45-degree field of view: 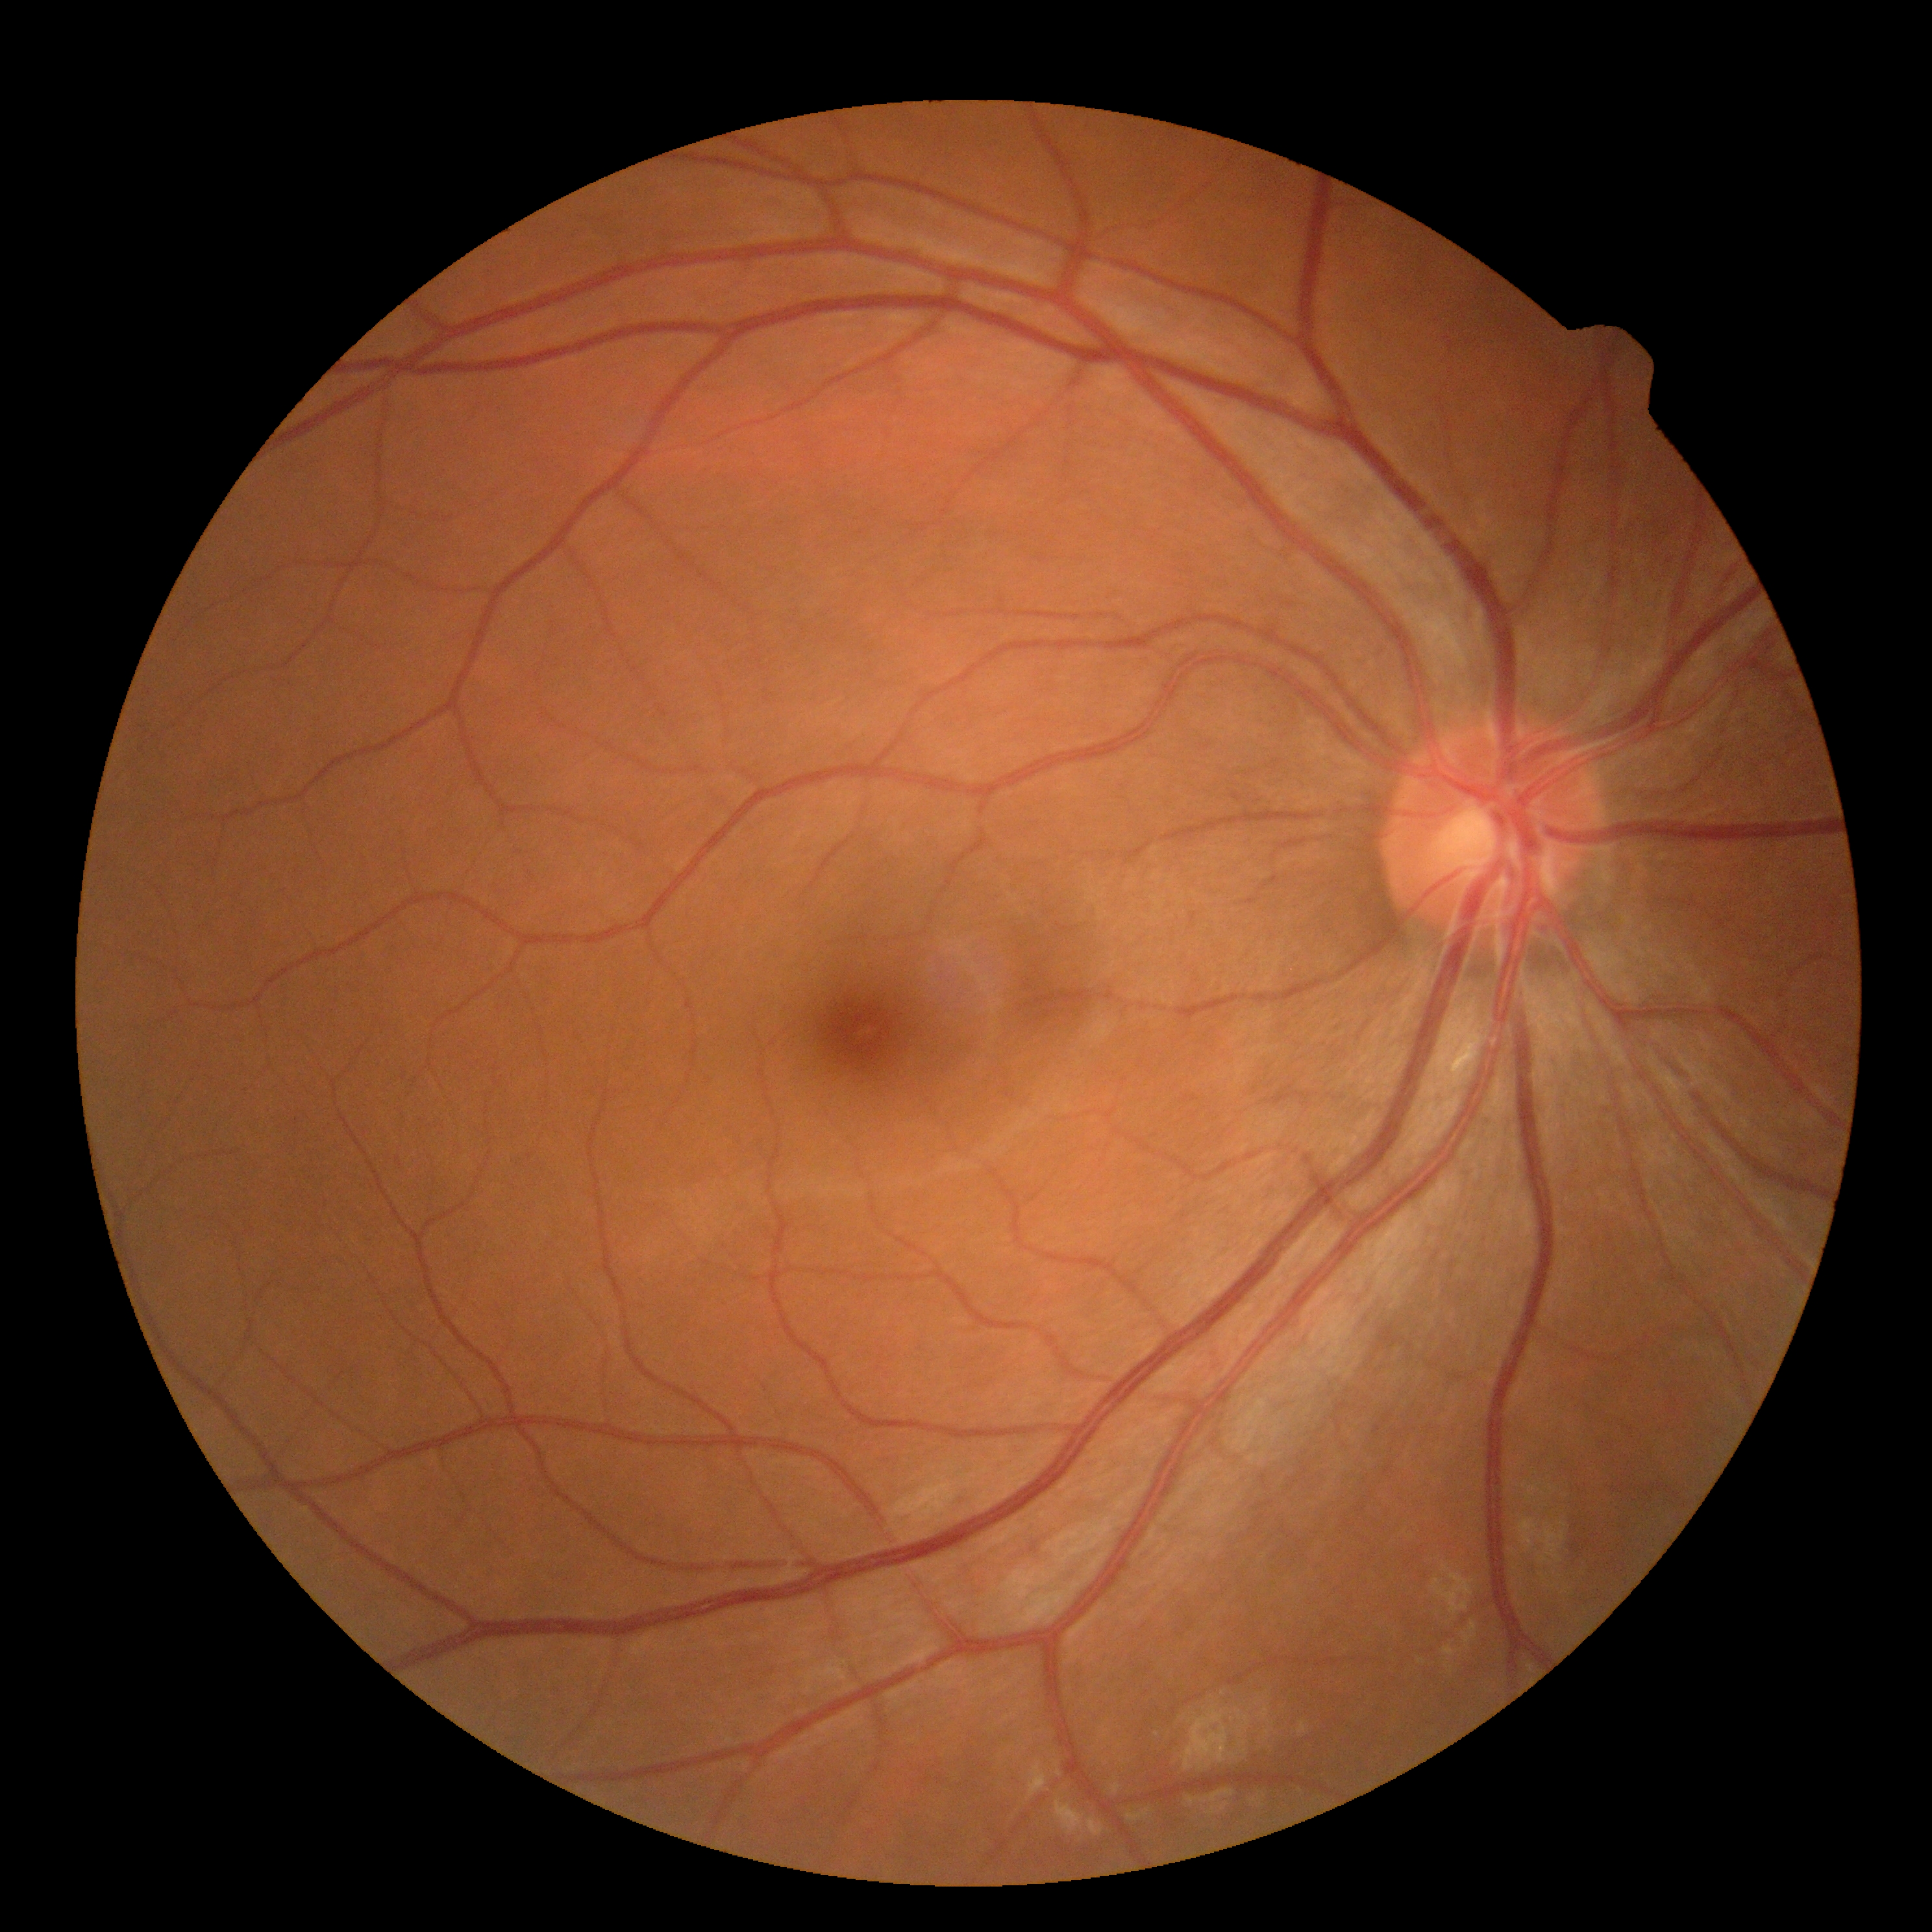
DR impression=no signs of DR; diabetic retinopathy (DR)=grade 0.